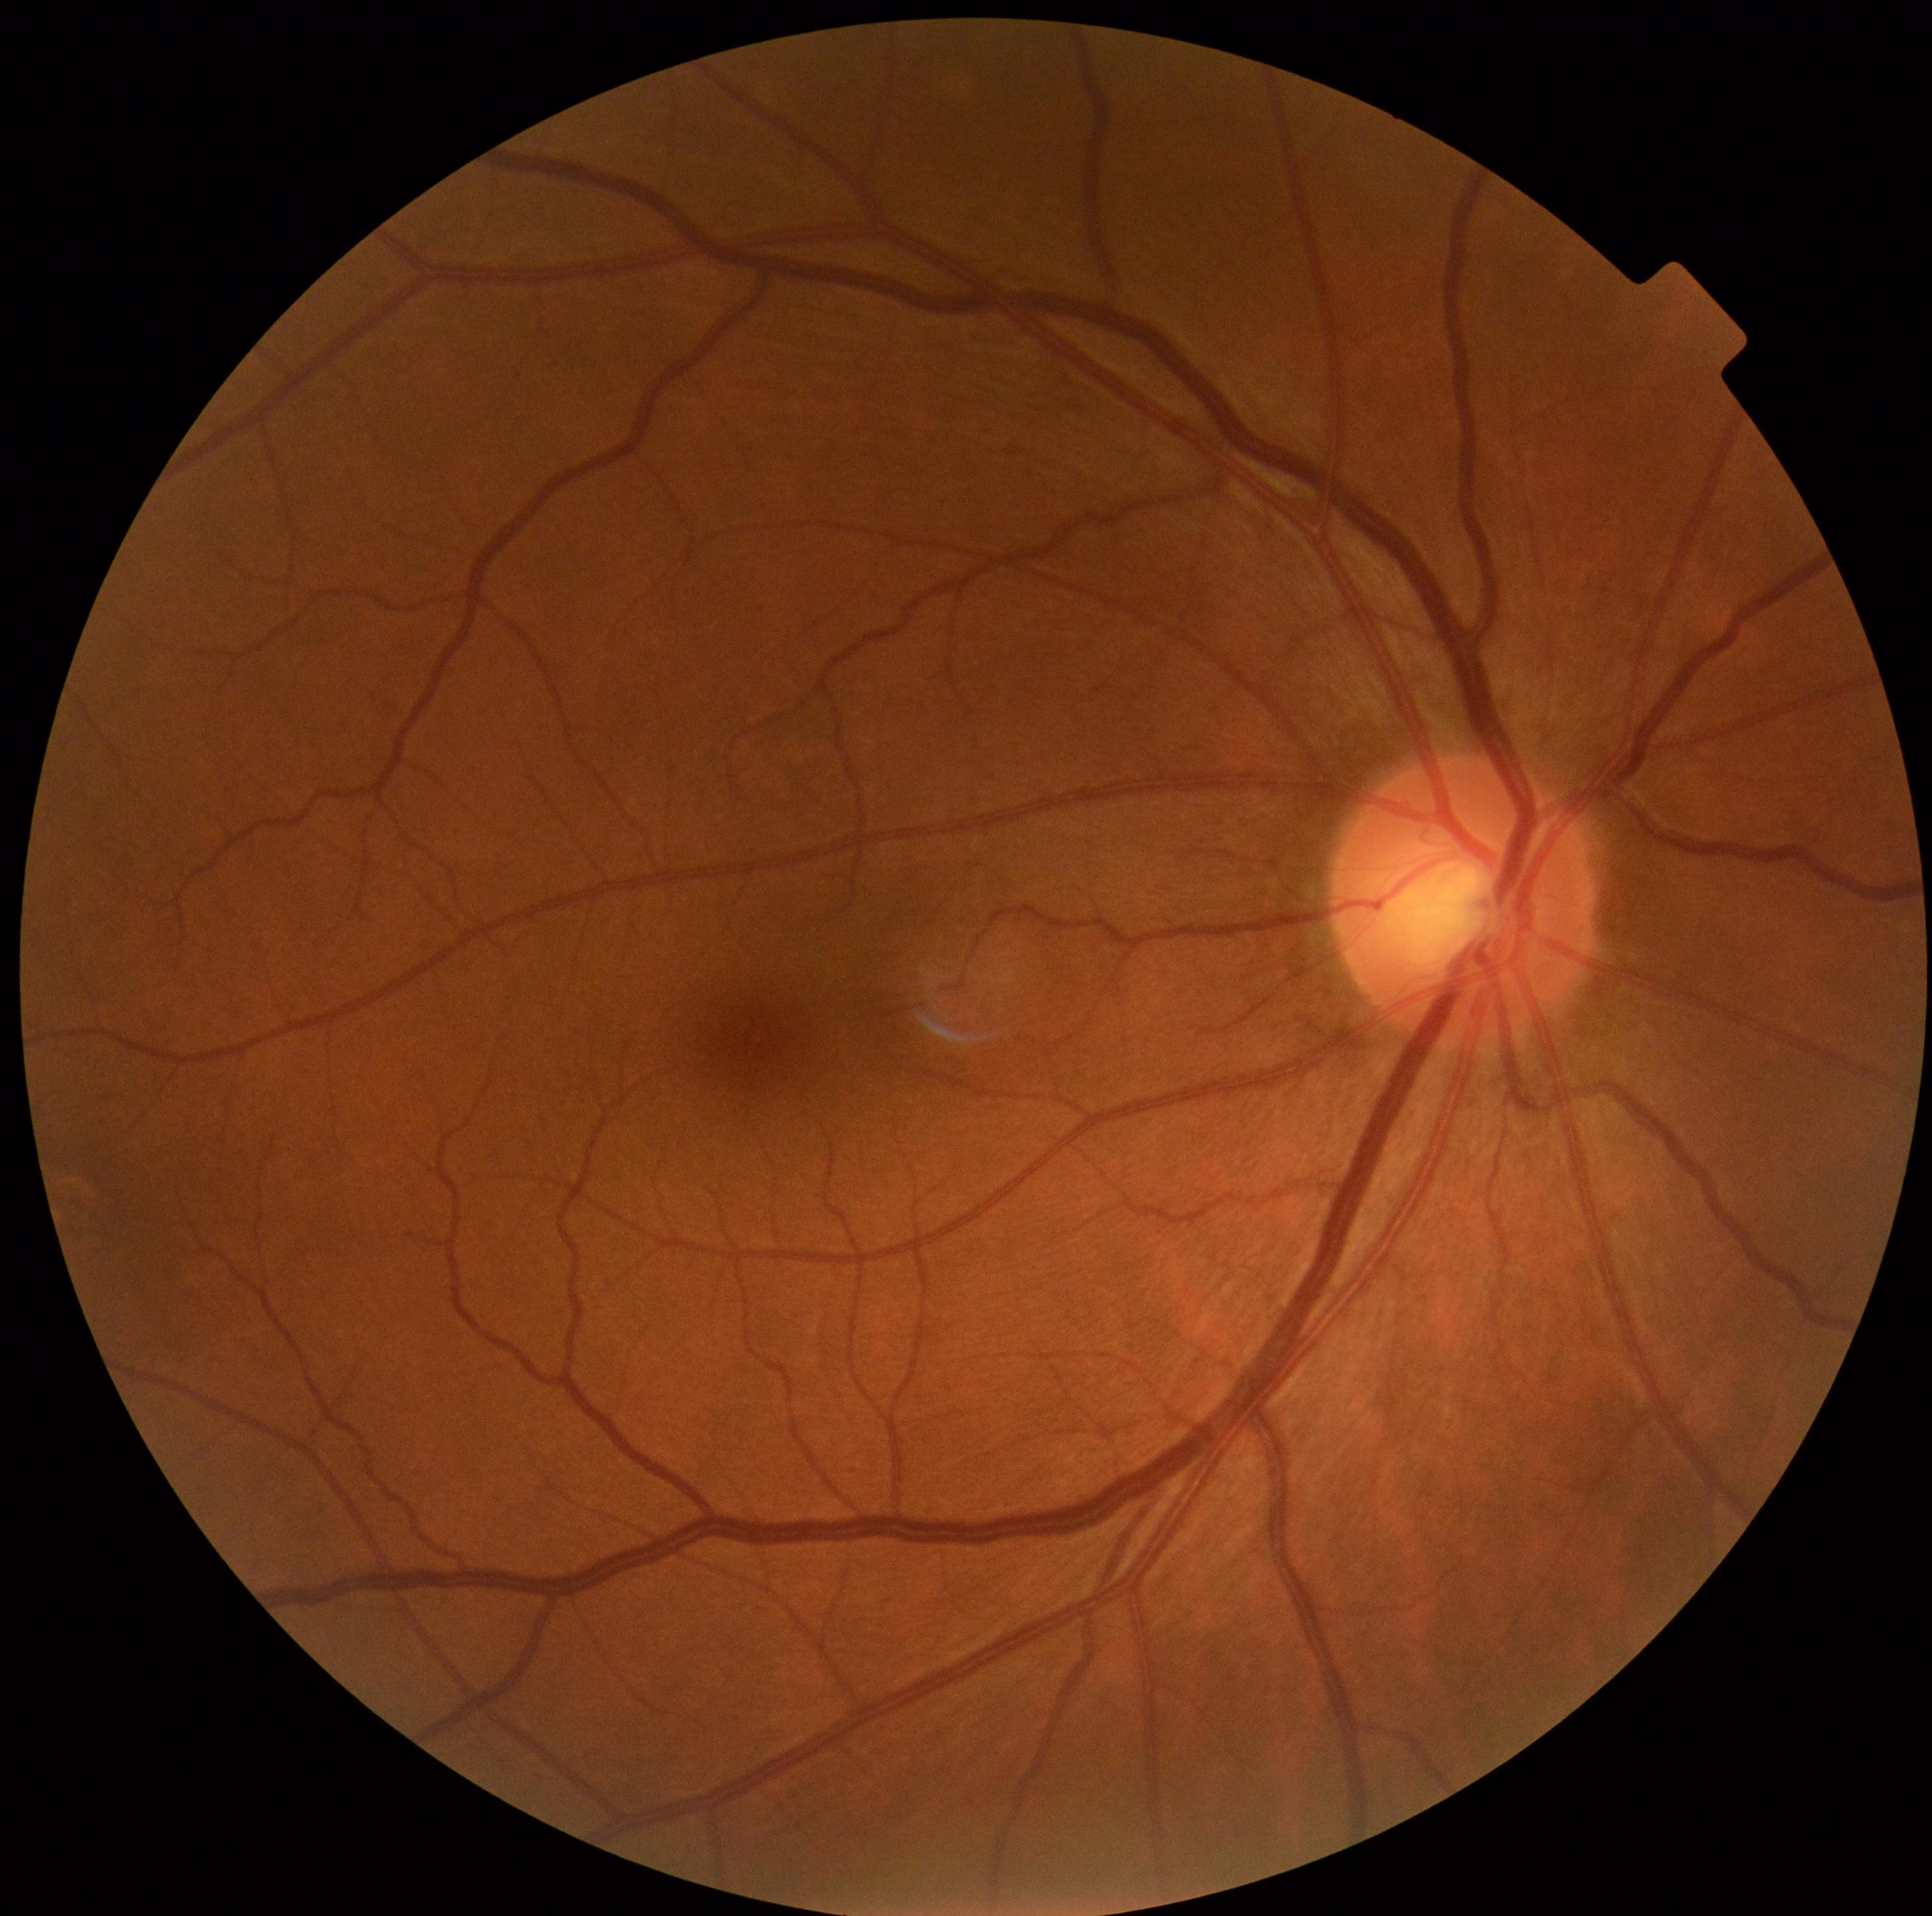

DR severity is no apparent retinopathy (grade 0).